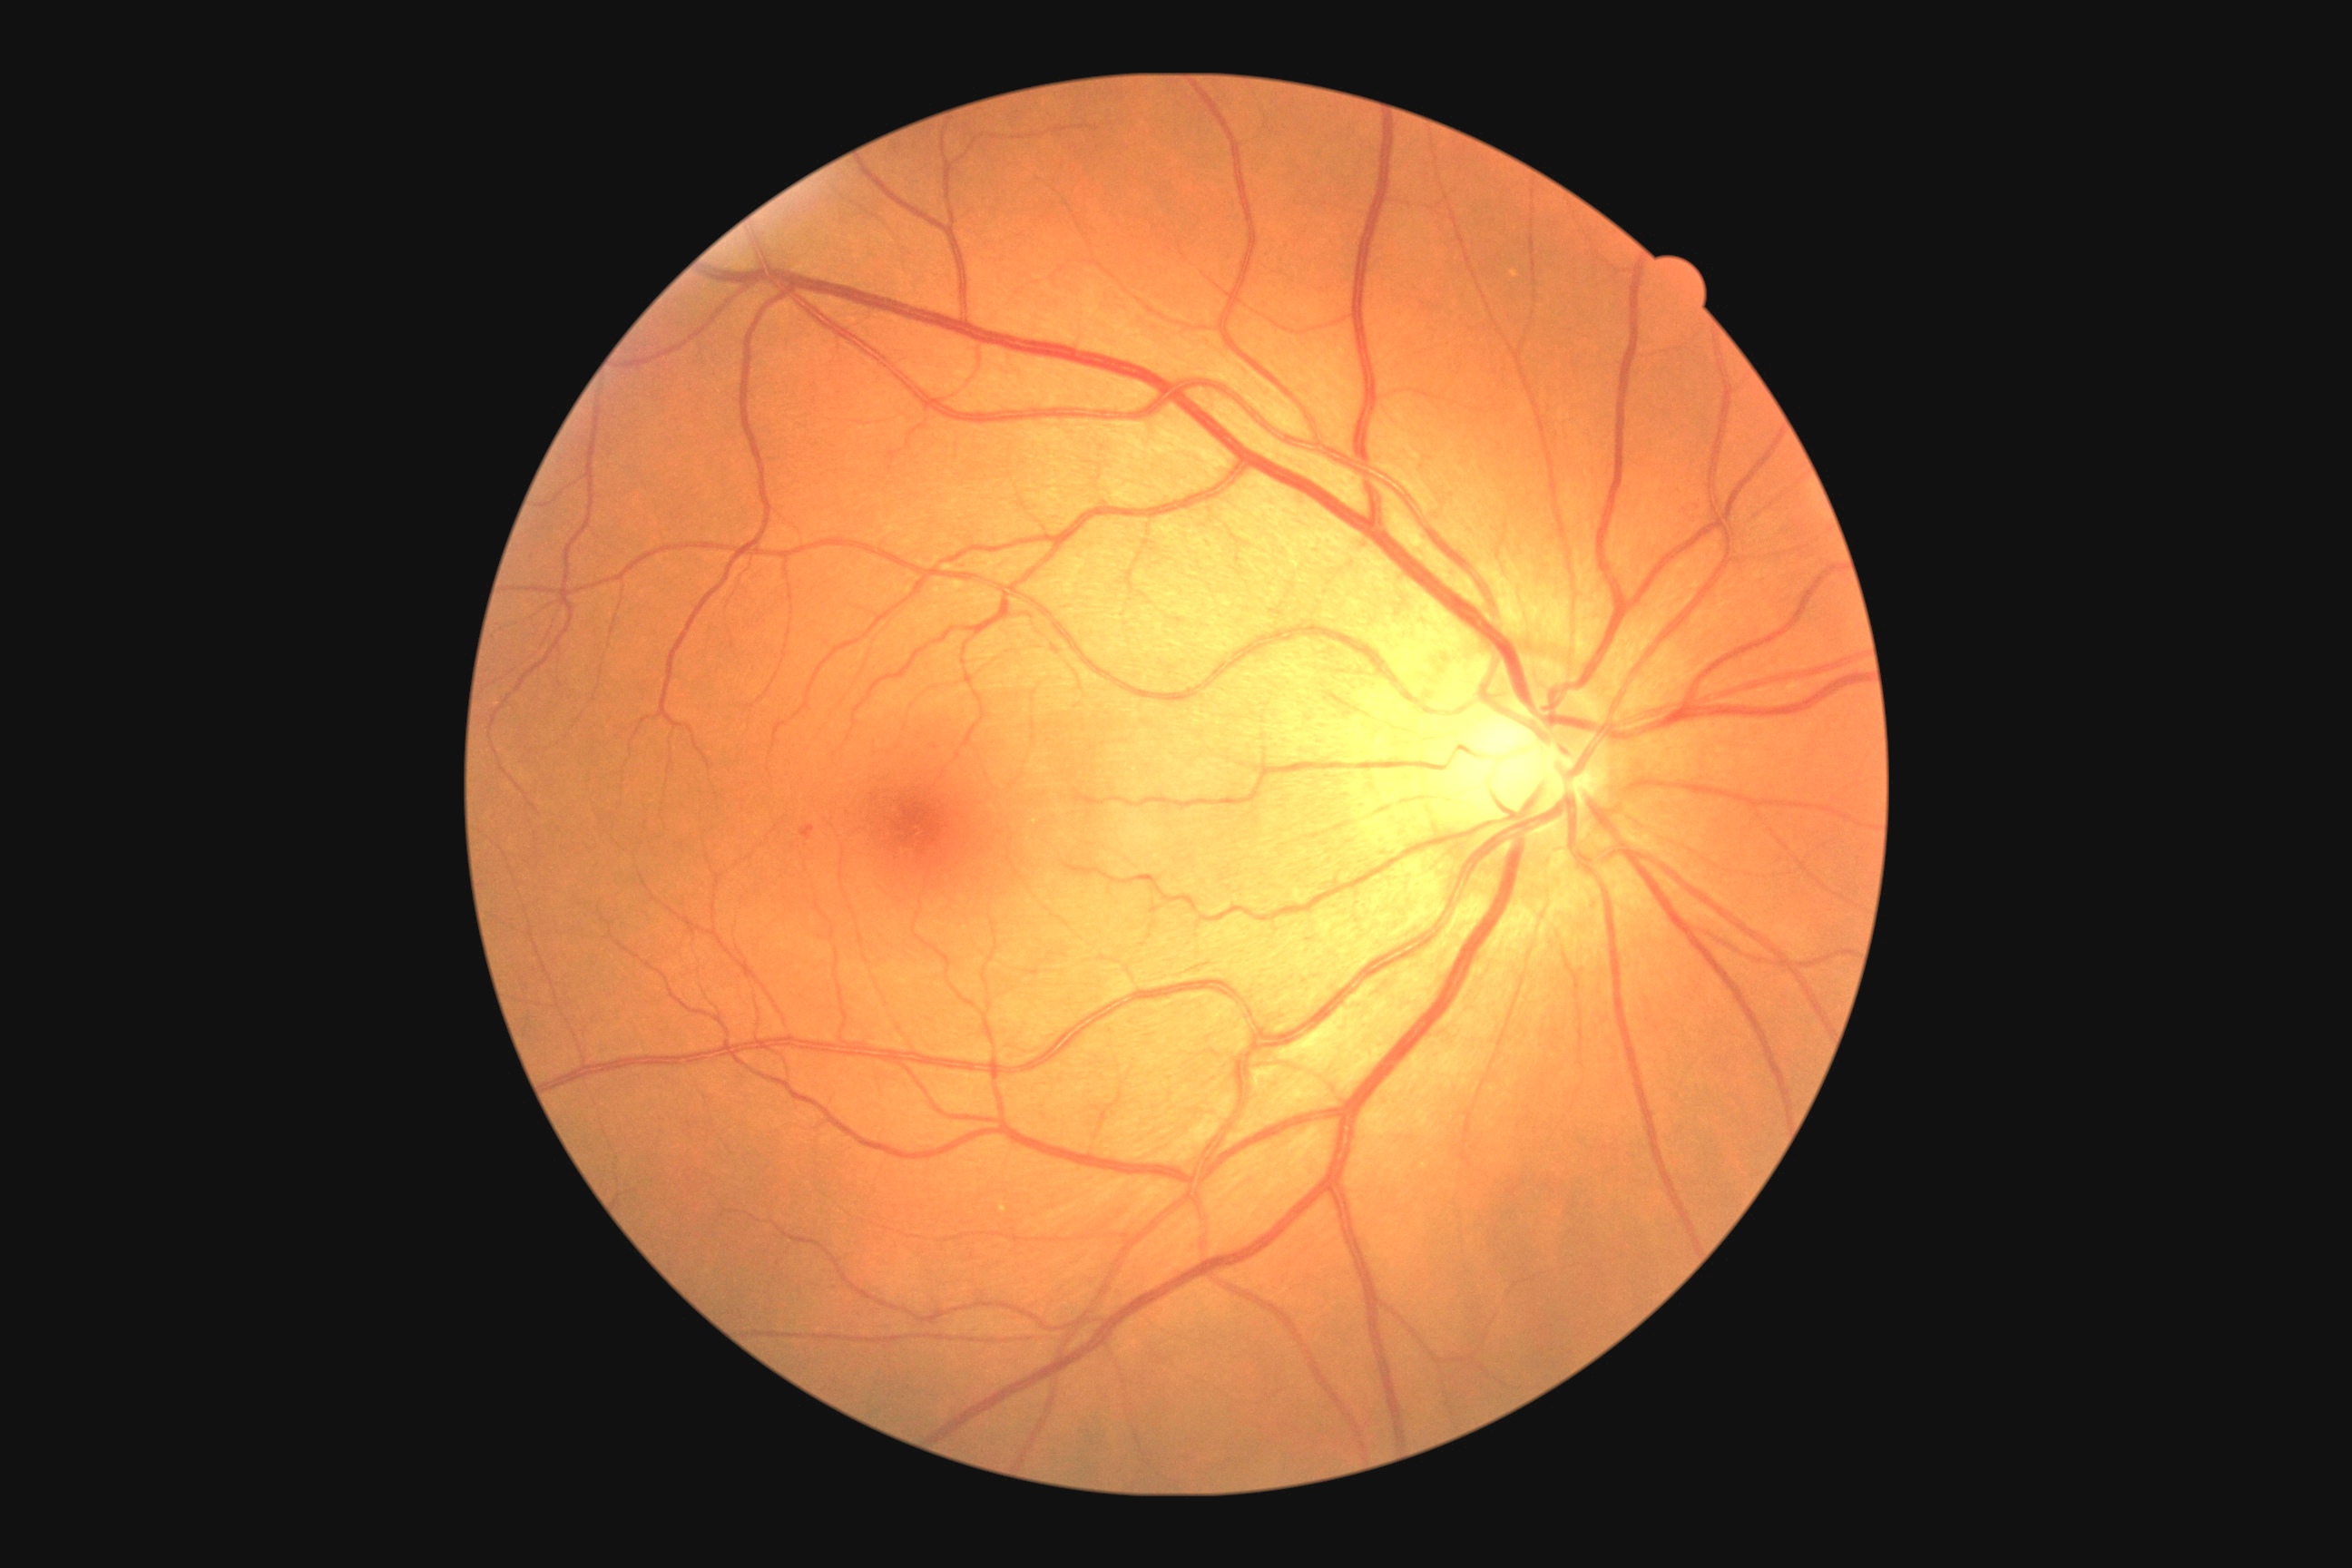 Diabetic retinopathy (DR) is 1; non-proliferative diabetic retinopathy
soft exudates (SEs) = absent
hard exudates (EXs) = absent
microaneurysms (MAs) = region(801, 825, 816, 841)
hemorrhages (HEs) = absent